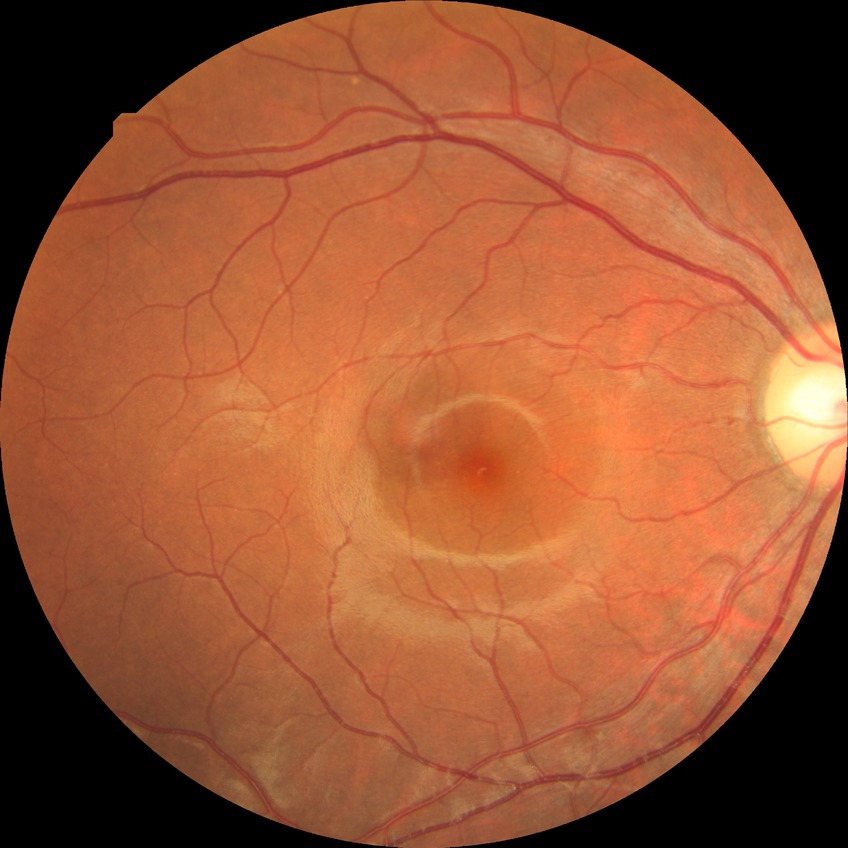 Diabetic retinopathy (DR) is NDR (no diabetic retinopathy).